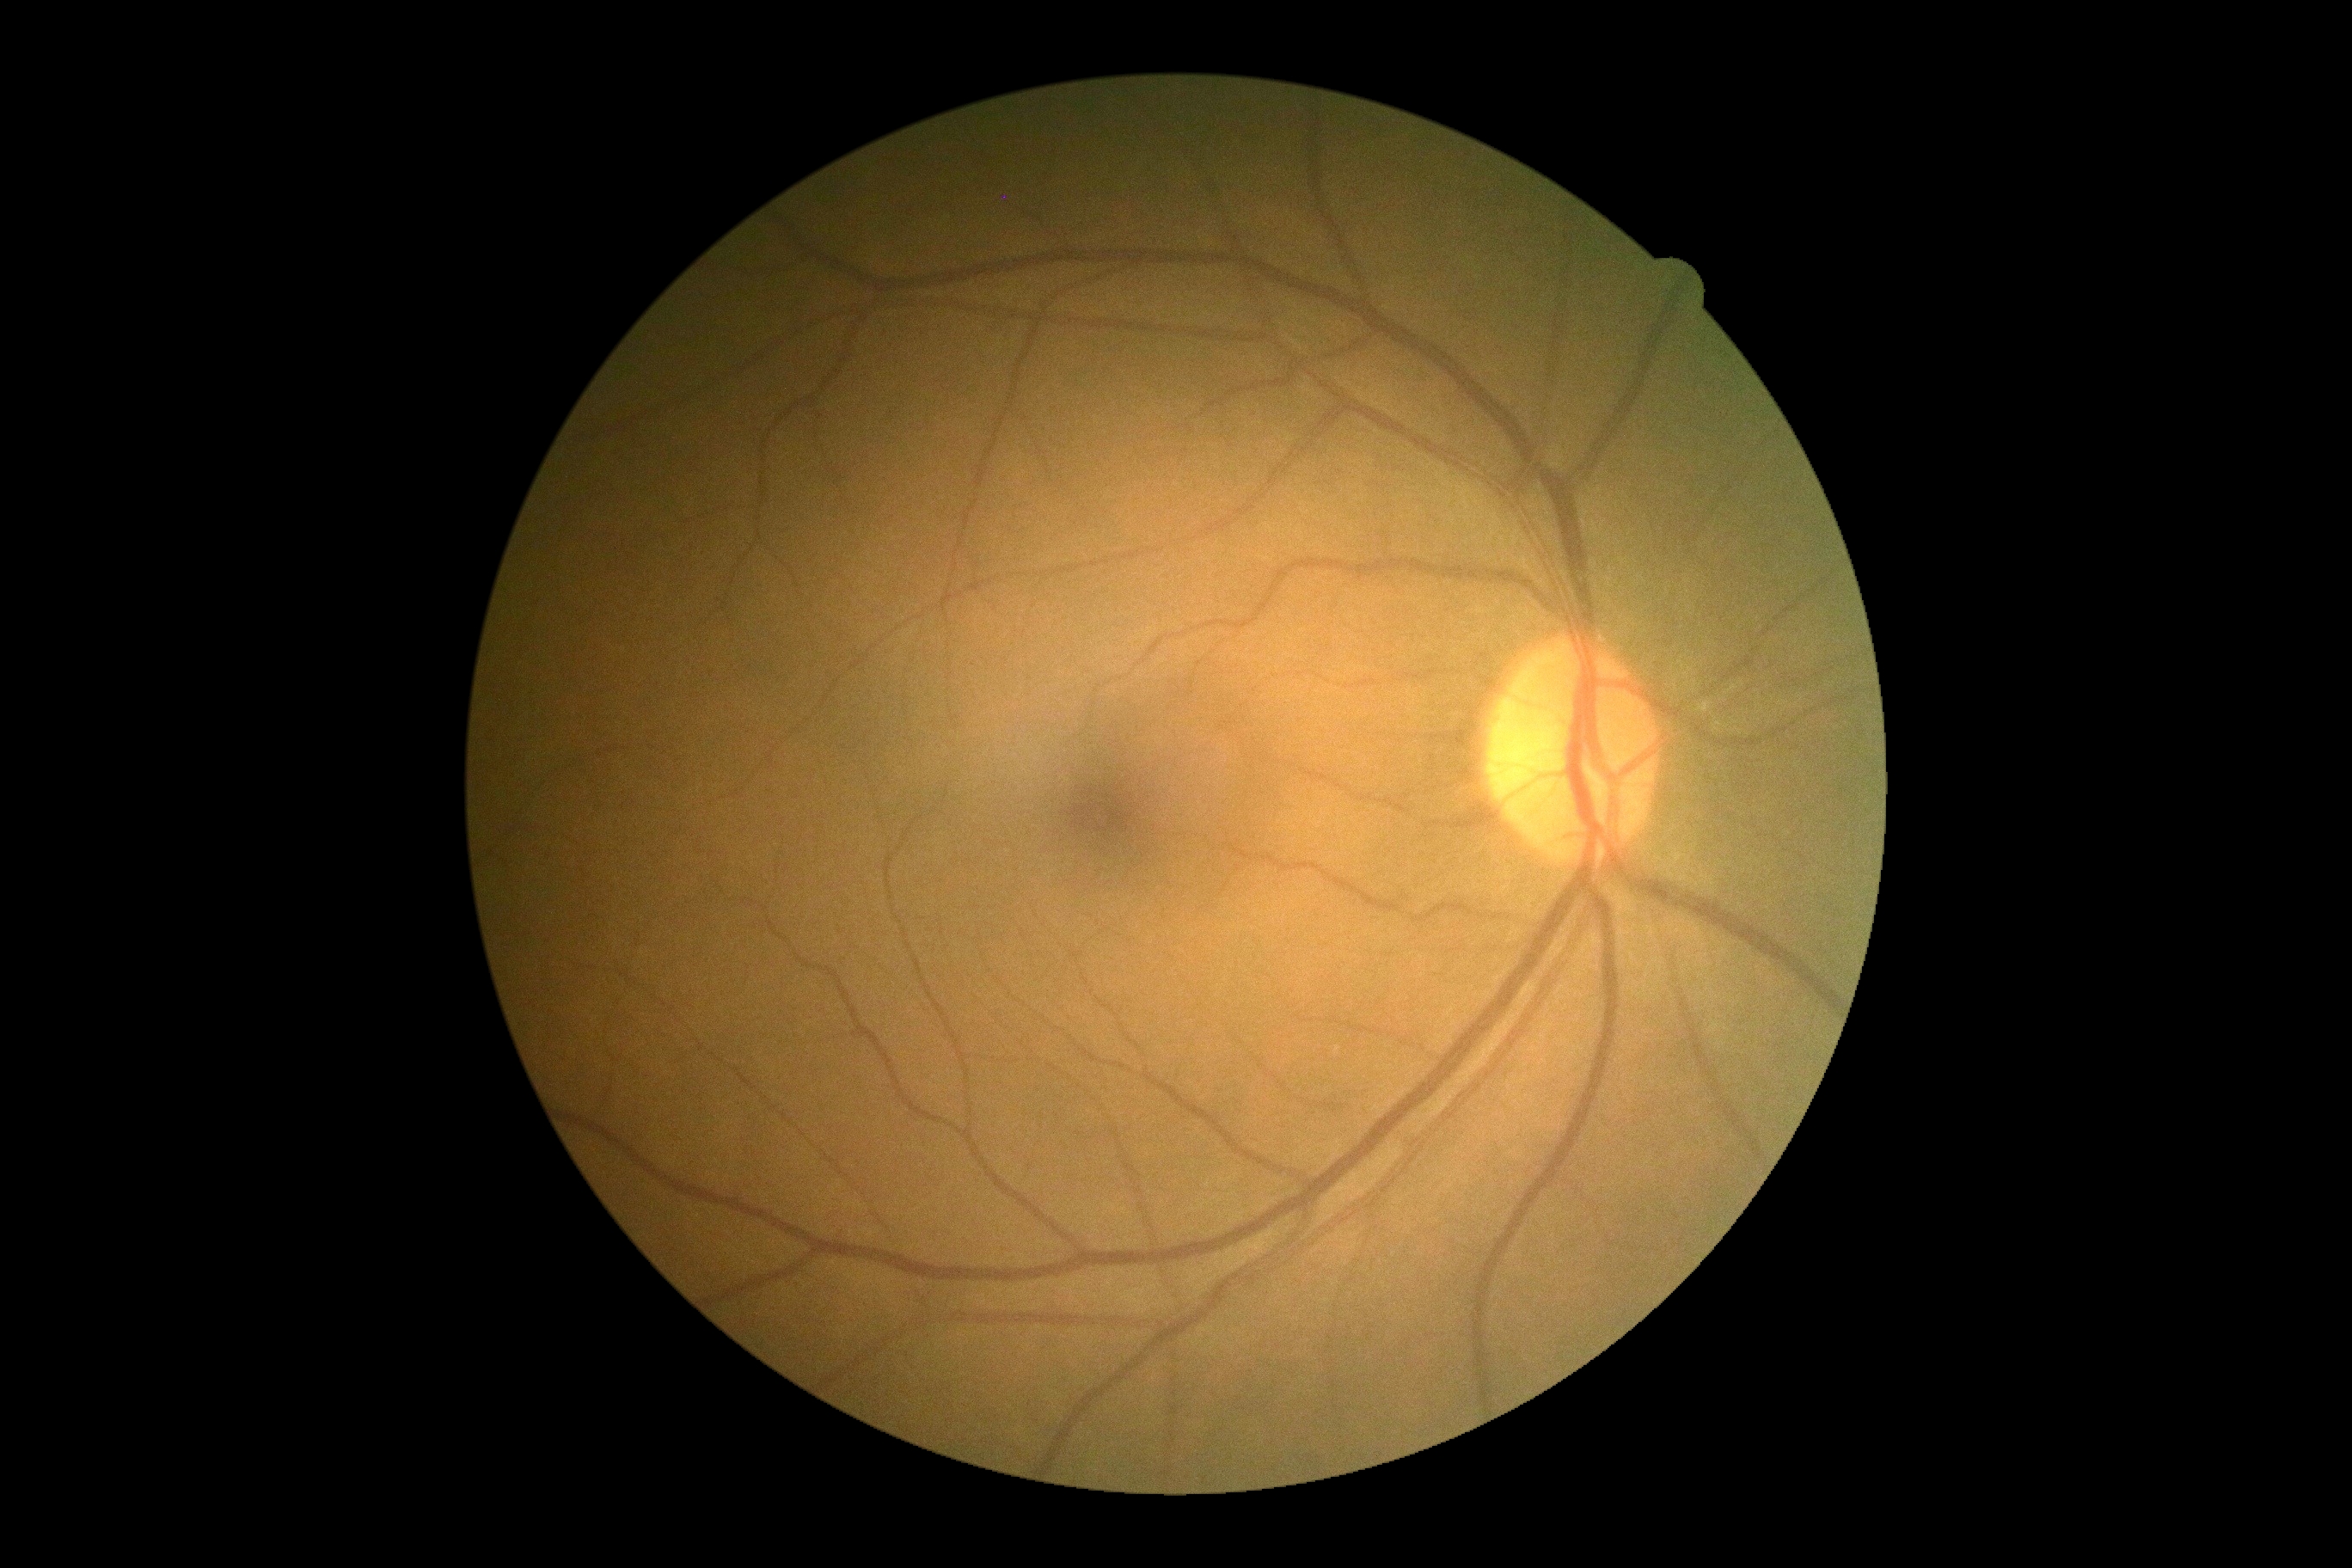

retinopathy grade@0 — no visible signs of diabetic retinopathy; DR impression@negative for DR.